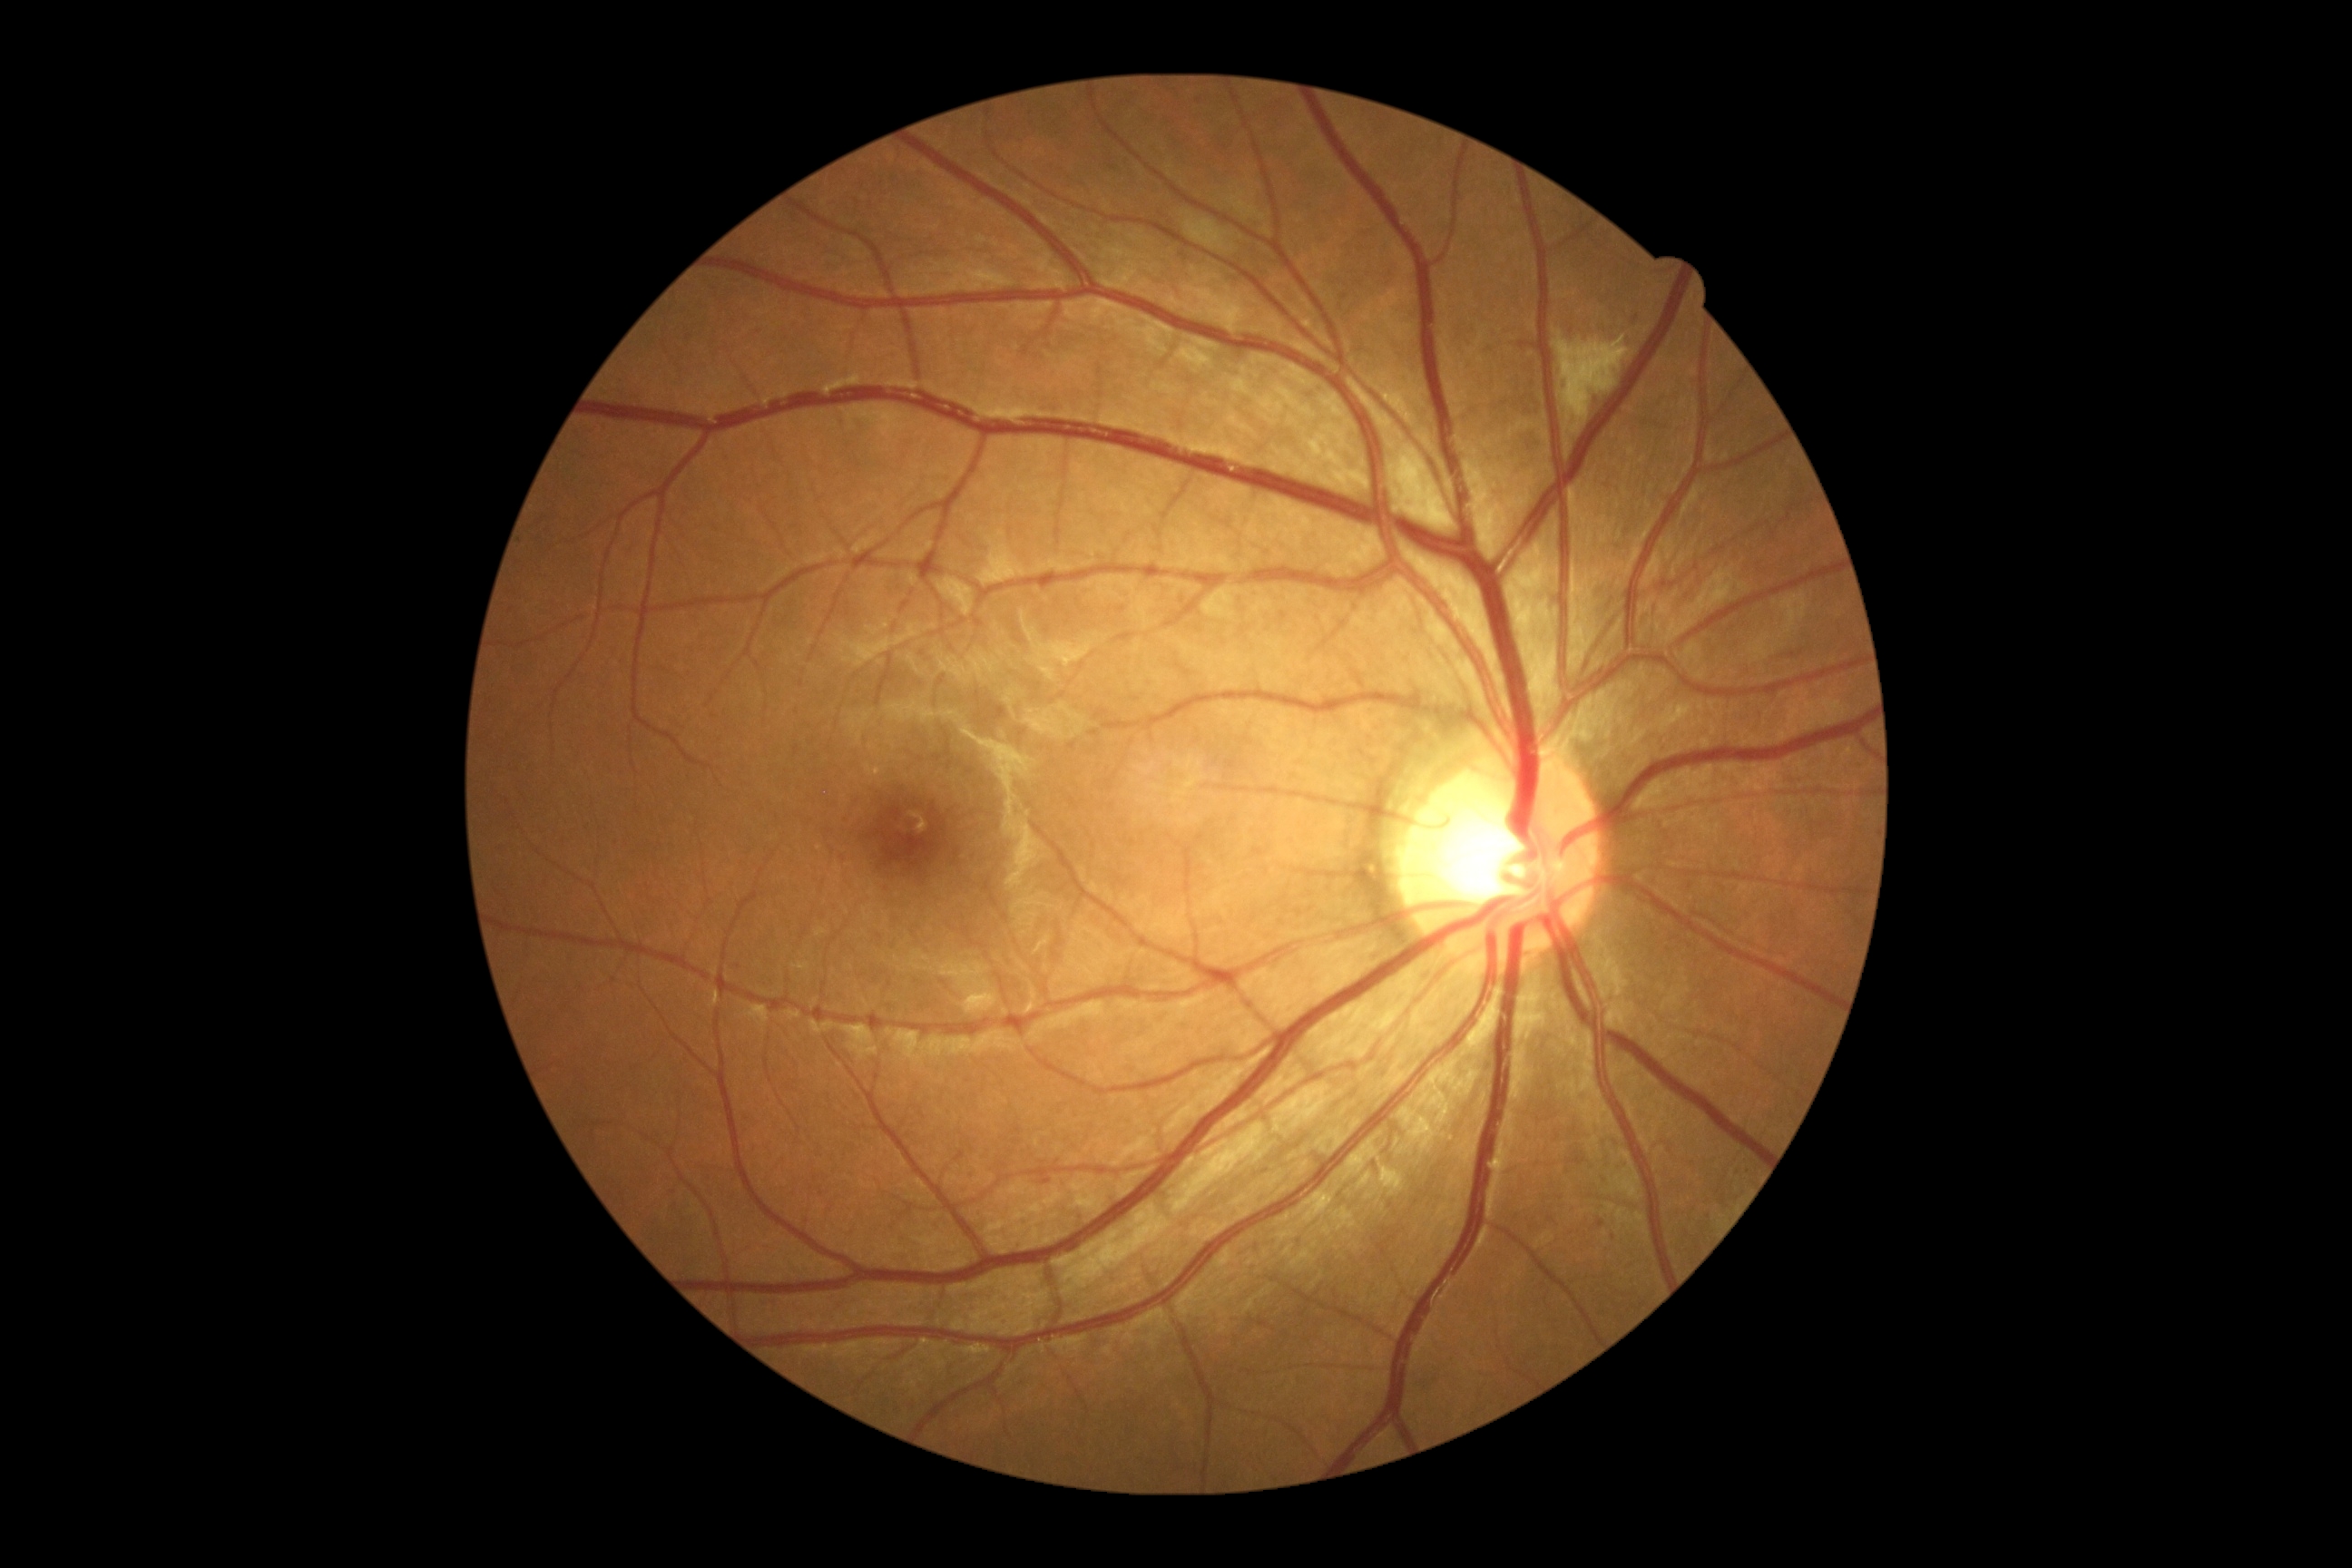

Annotations:
- DR grade: 2/4 — more than just microaneurysms but less than severe NPDR